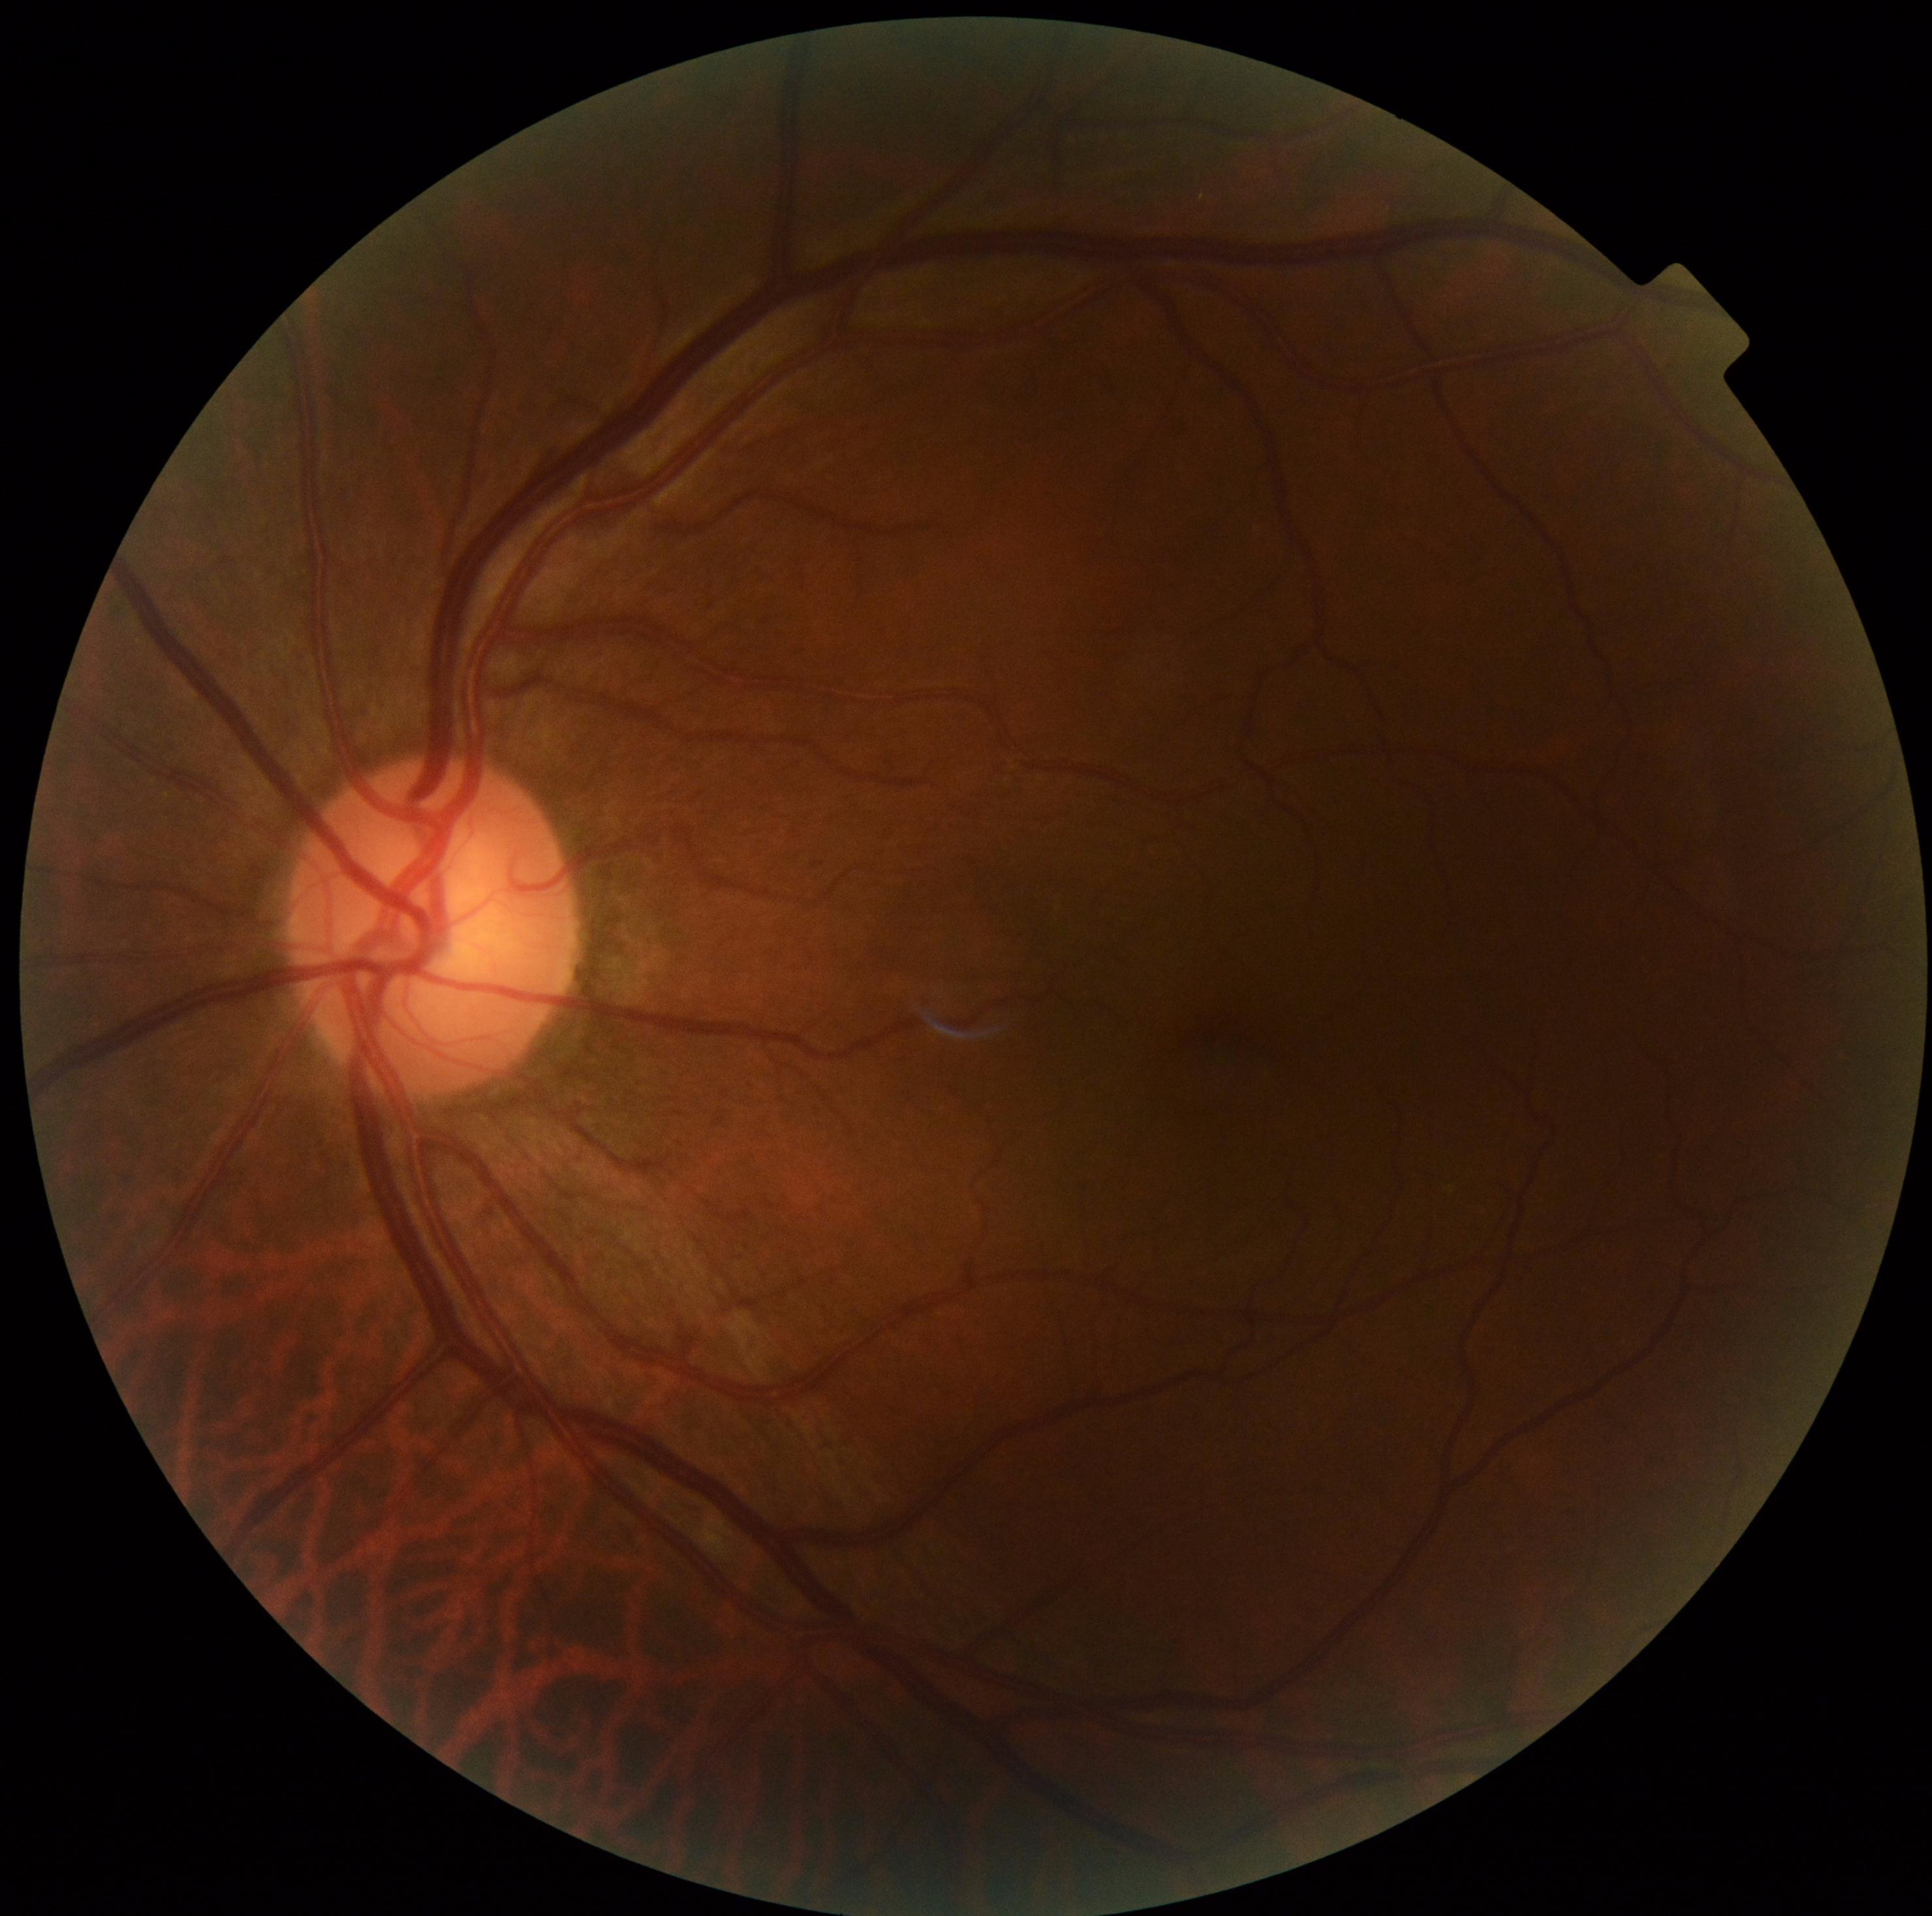
DR grade is no apparent diabetic retinopathy (0). No apparent diabetic retinopathy.